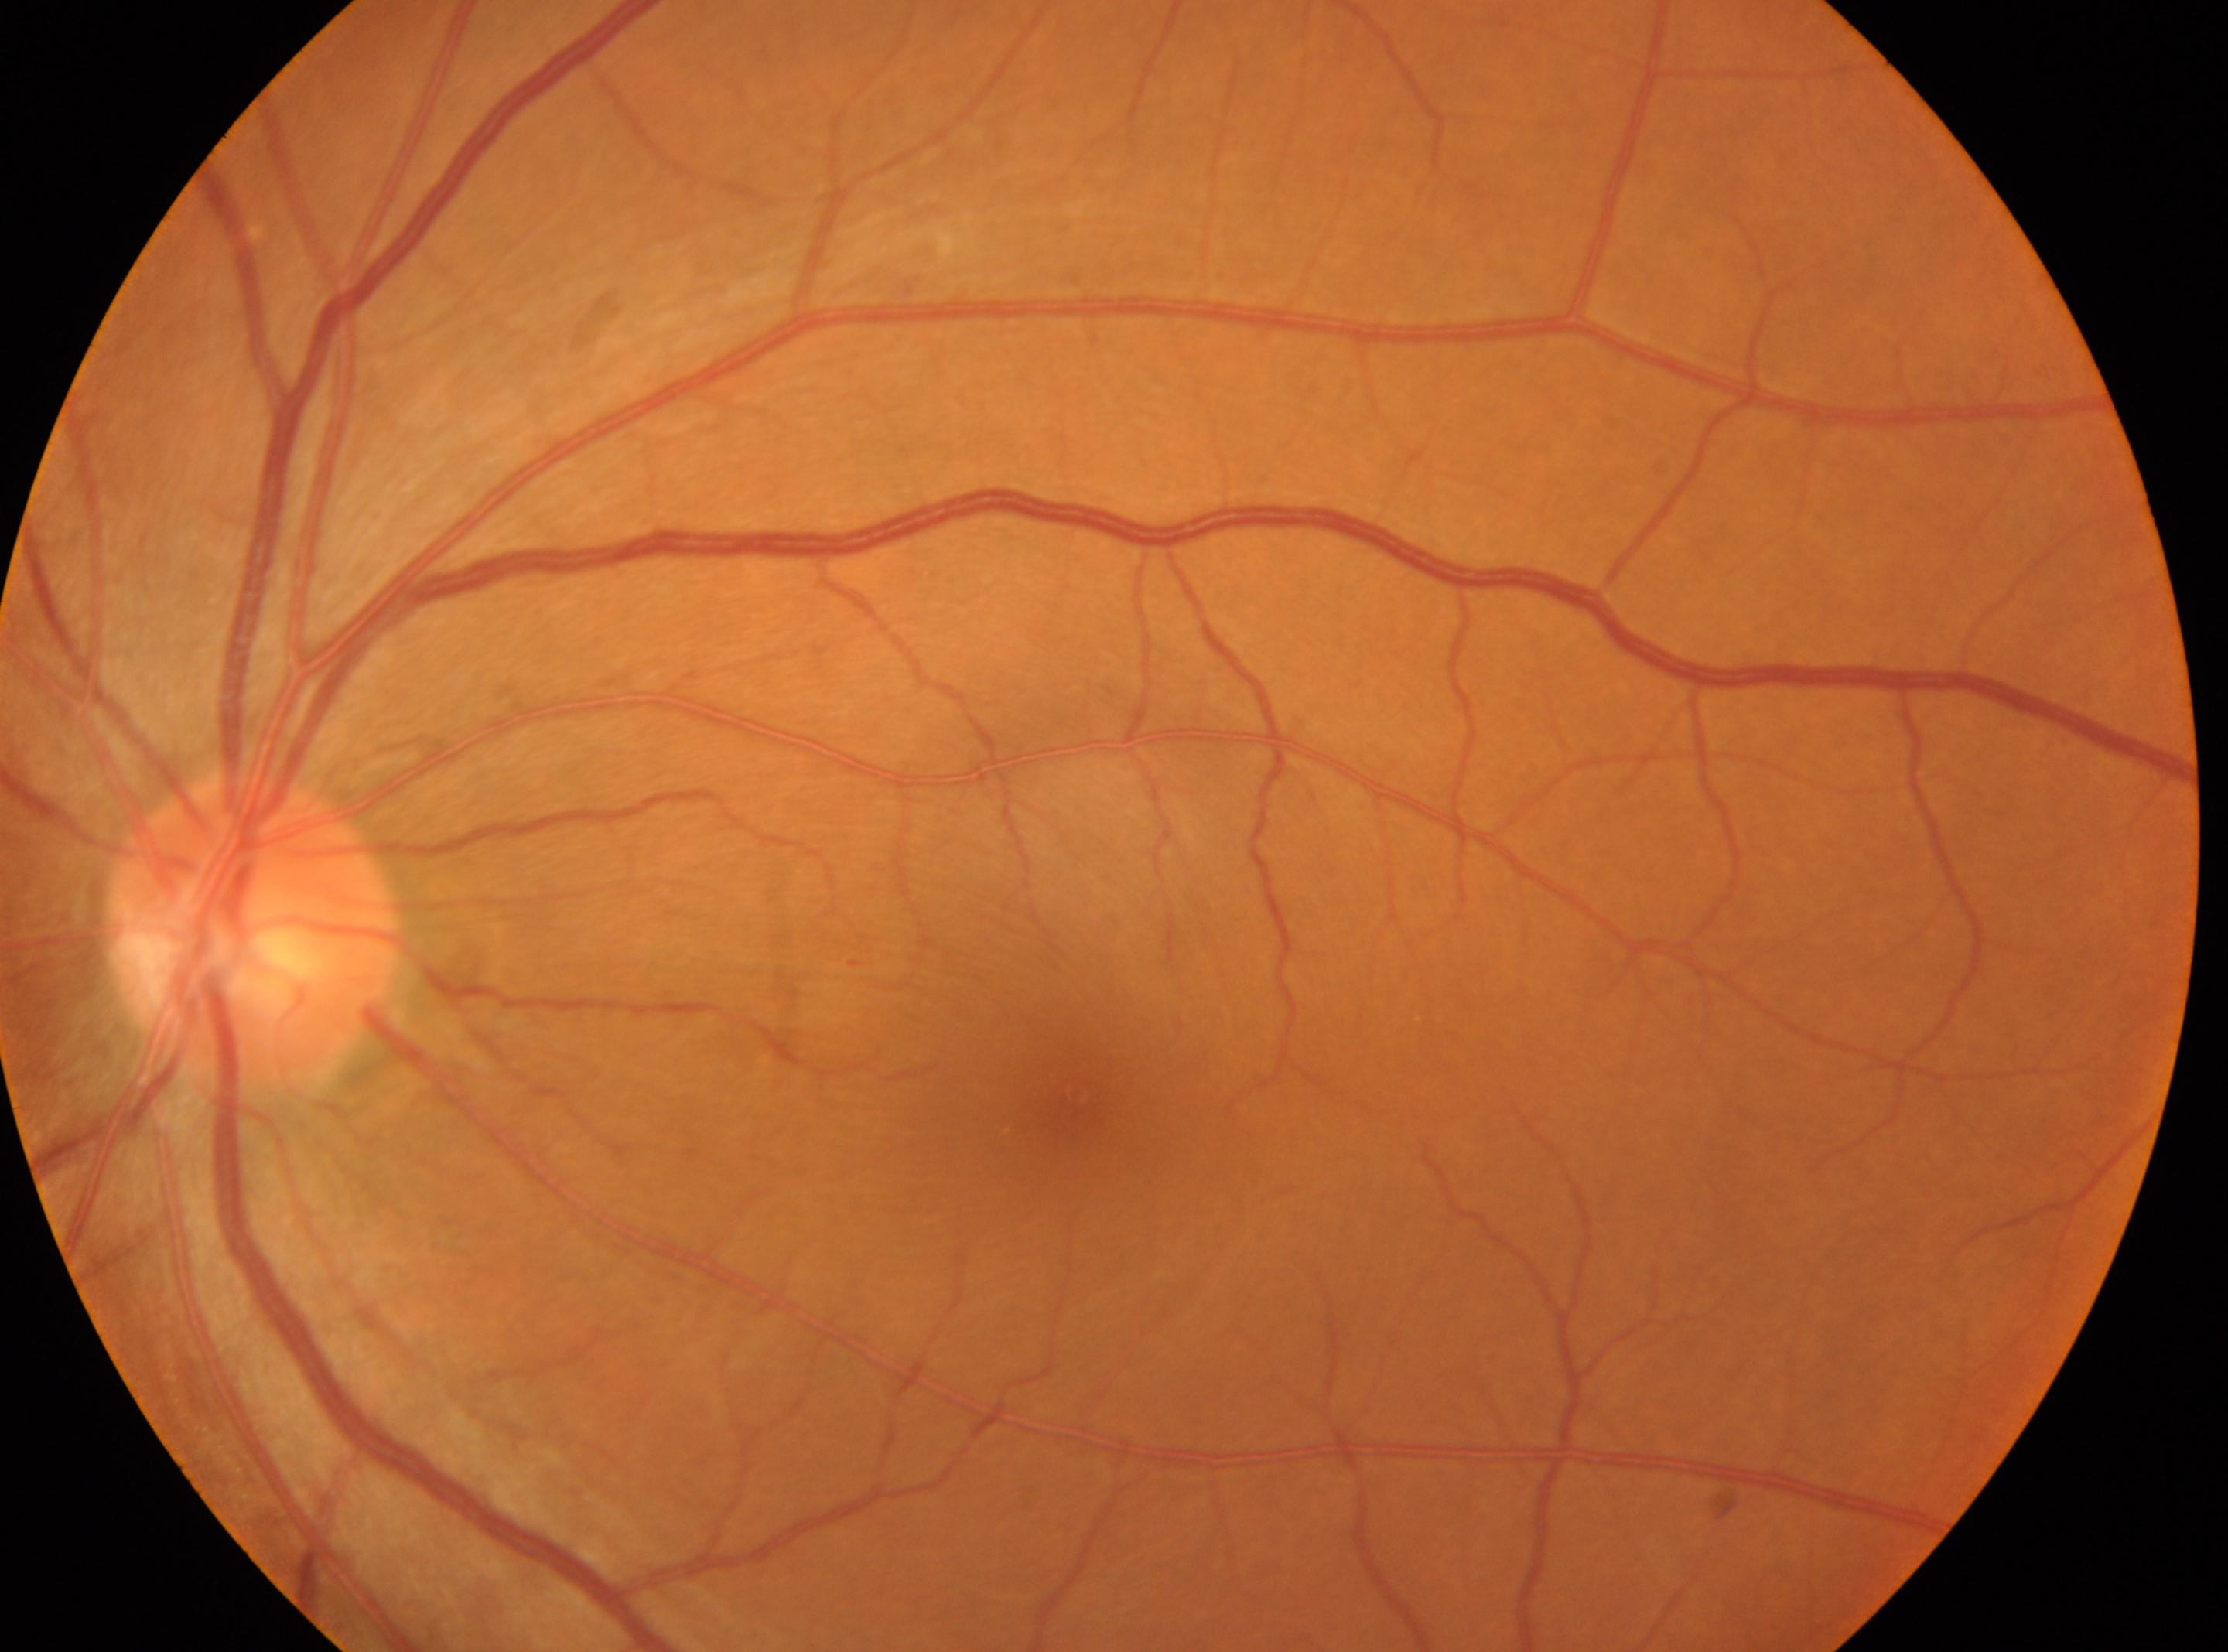

DR: 0. Fovea located at 1074, 1092. Optic disk located at 253, 930. The image shows the oculus sinister. No signs of diabetic retinopathy.